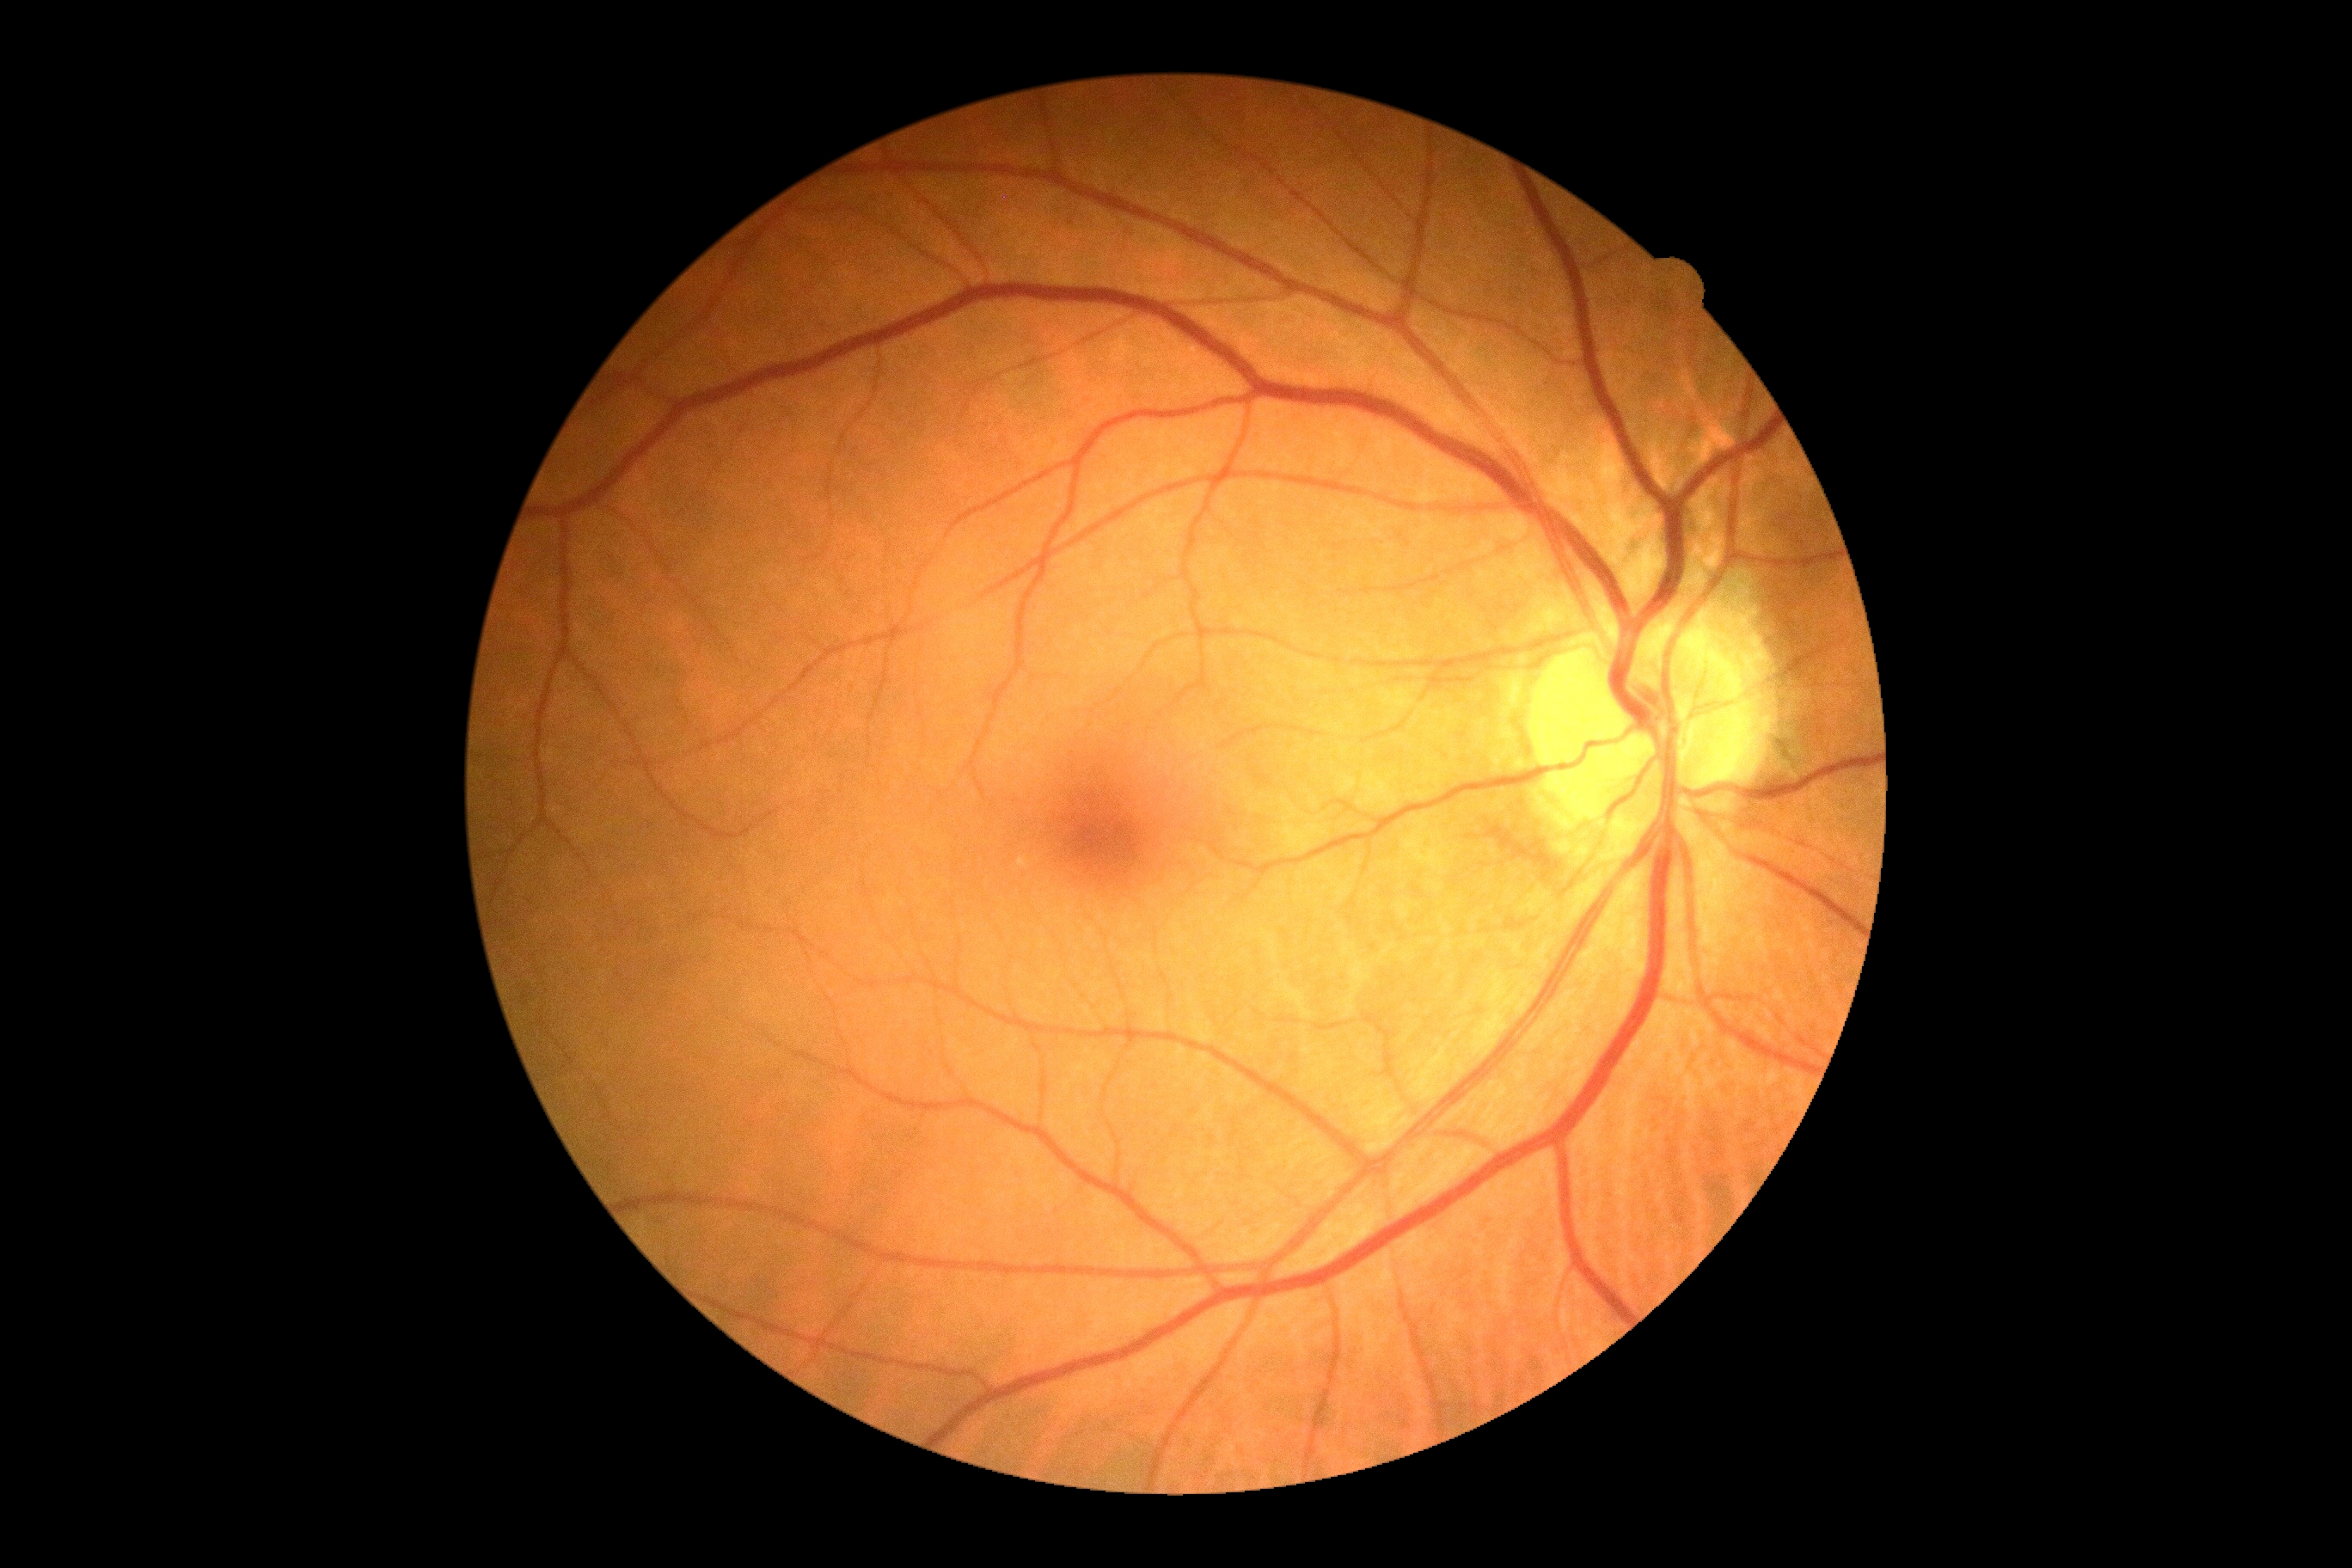

diabetic retinopathy=0/4.